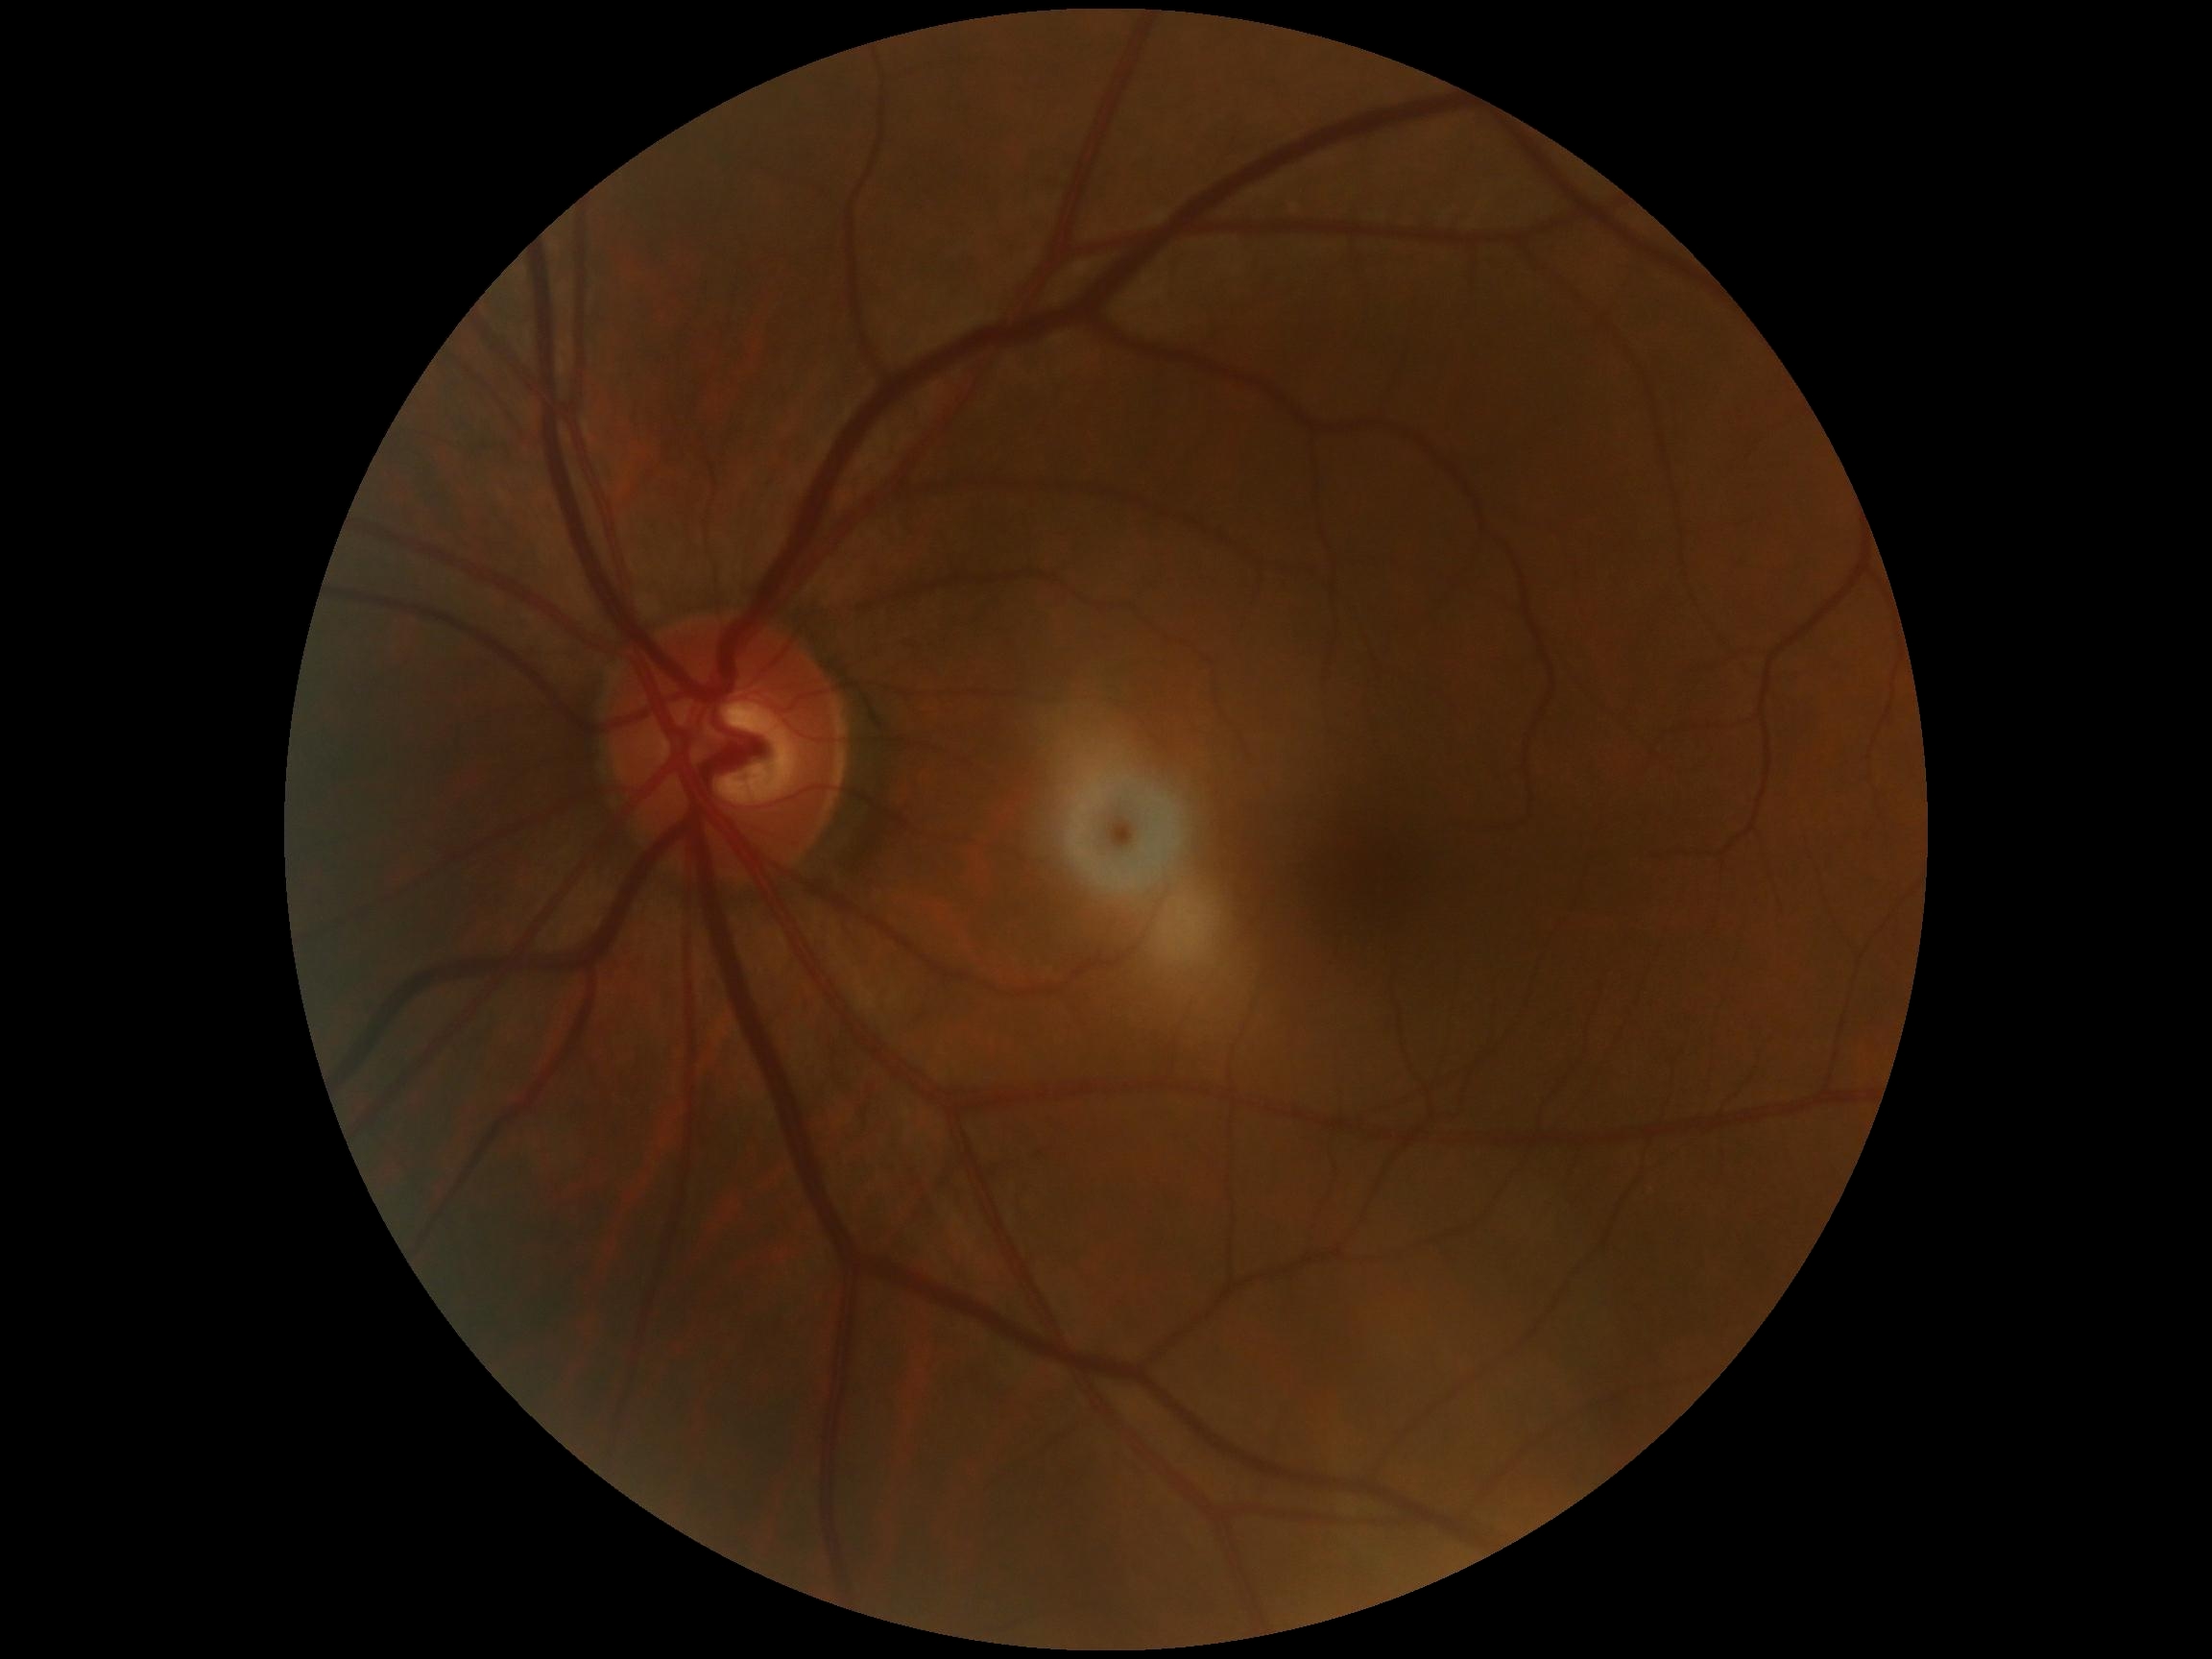 DR stage=no apparent retinopathy (grade 0) — no visible signs of diabetic retinopathy.